45° FOV. Fundus photo:
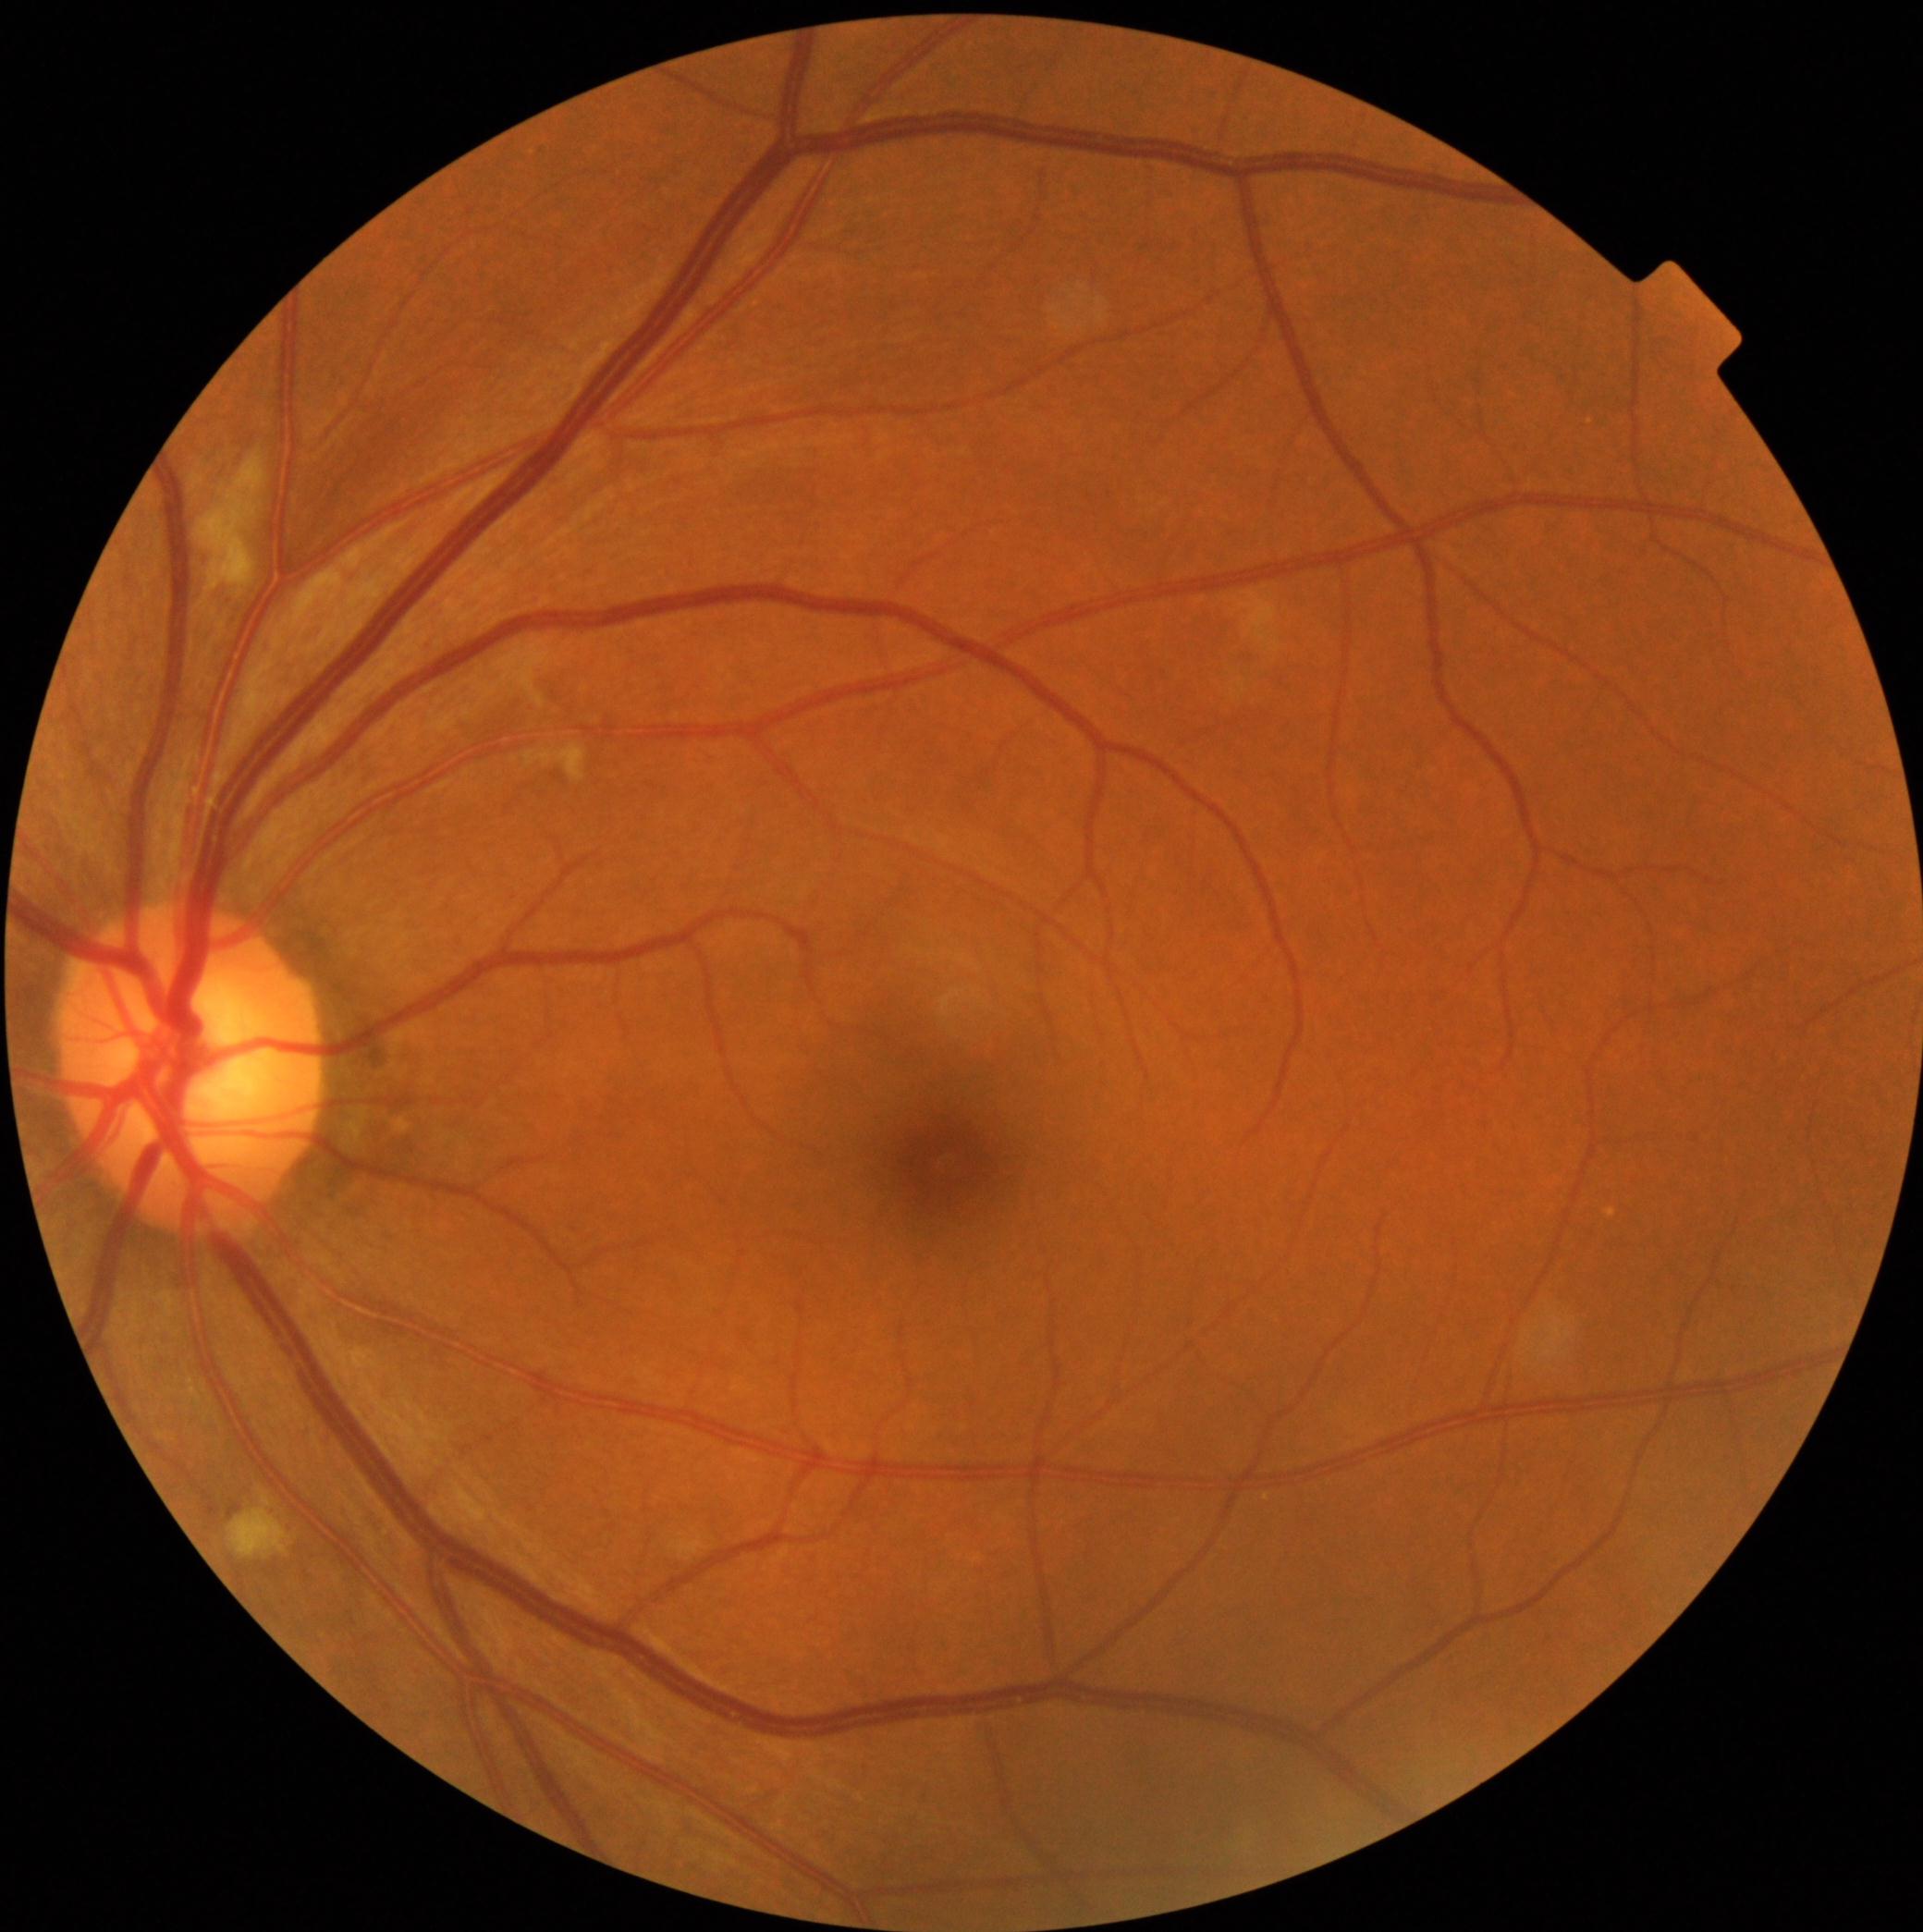
{"dr_category": "non-proliferative diabetic retinopathy", "dr_grade": "2/4"}